No pharmacologic dilation · graded on the modified Davis scale · 45-degree field of view · camera: NIDEK AFC-230 · 848 x 848 pixels · color fundus photograph.
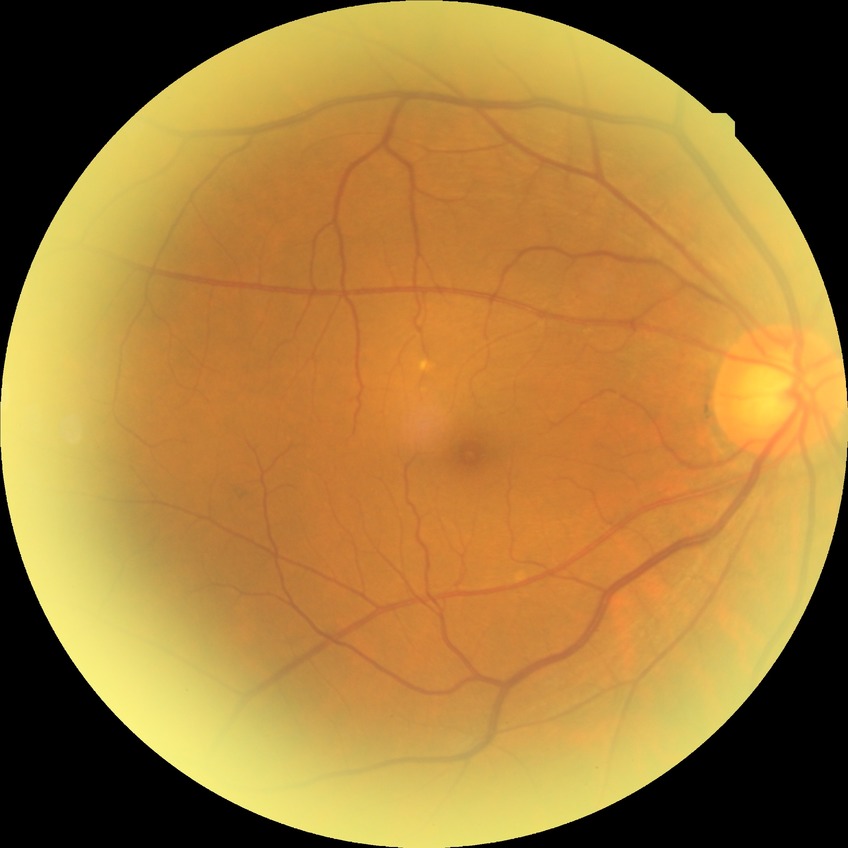

Diabetic retinopathy (DR): NDR (no diabetic retinopathy).